Acquired on the Phoenix ICON · wide-field fundus image from infant ROP screening.
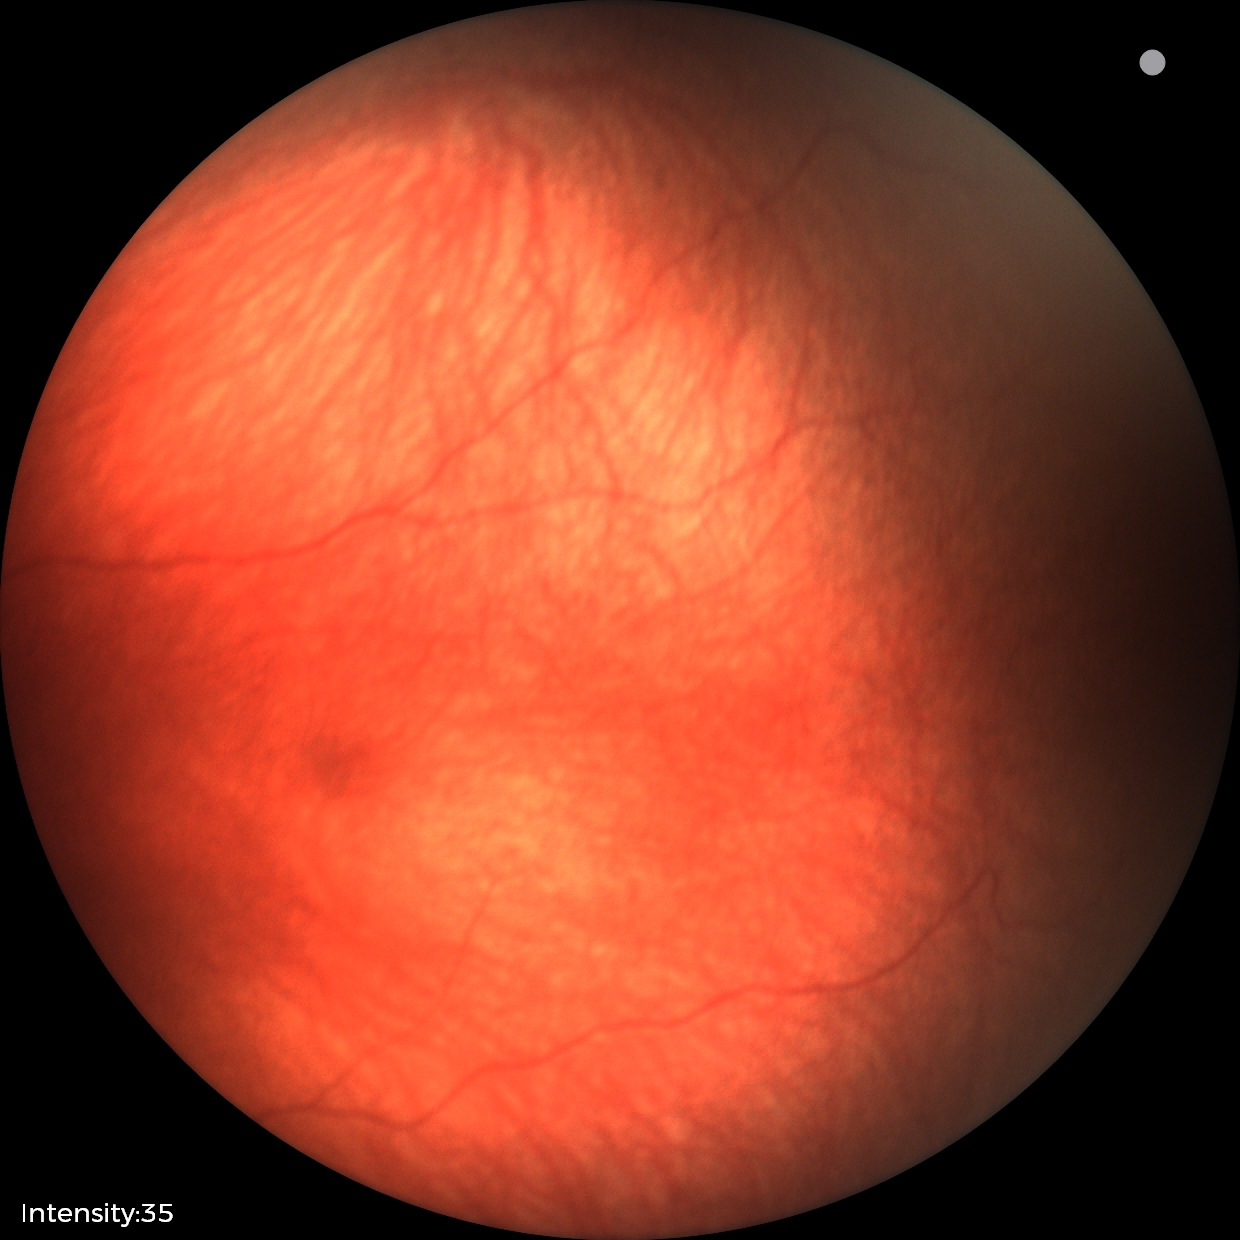 Diagnosis from this screening exam: retinal hemorrhages.